45° field of view.
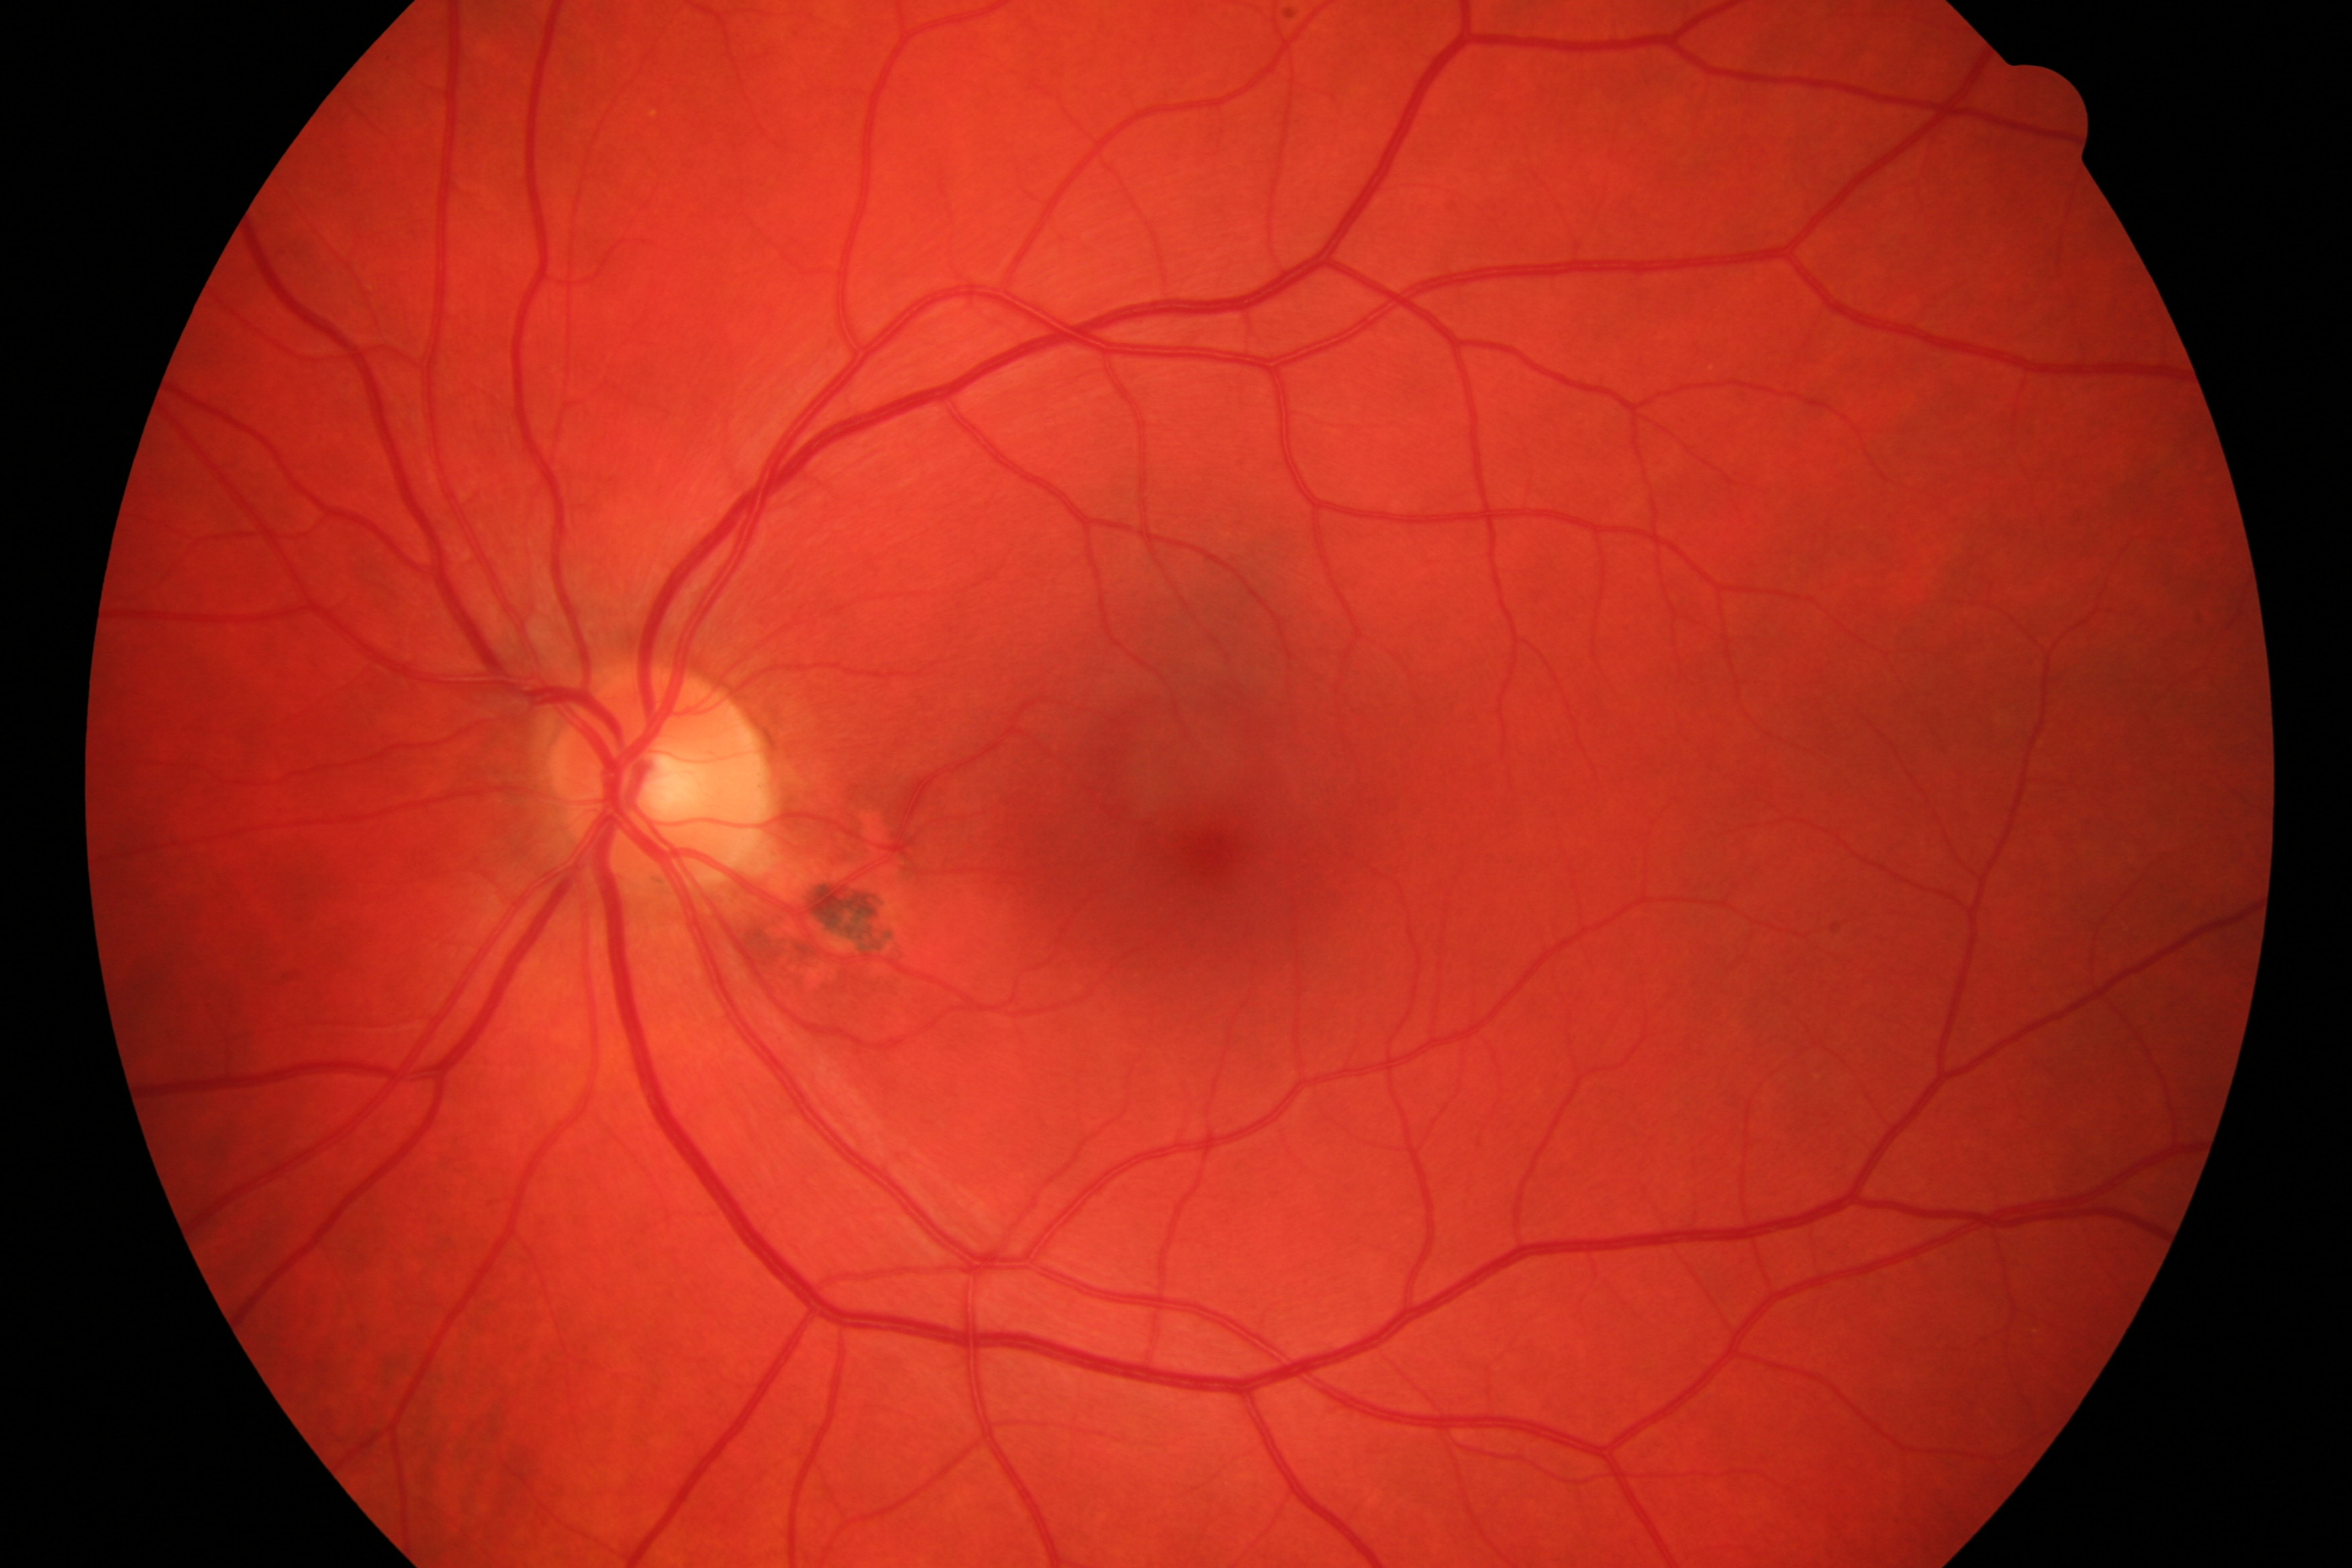
Diagnosis: DR.